Retinal fundus photograph
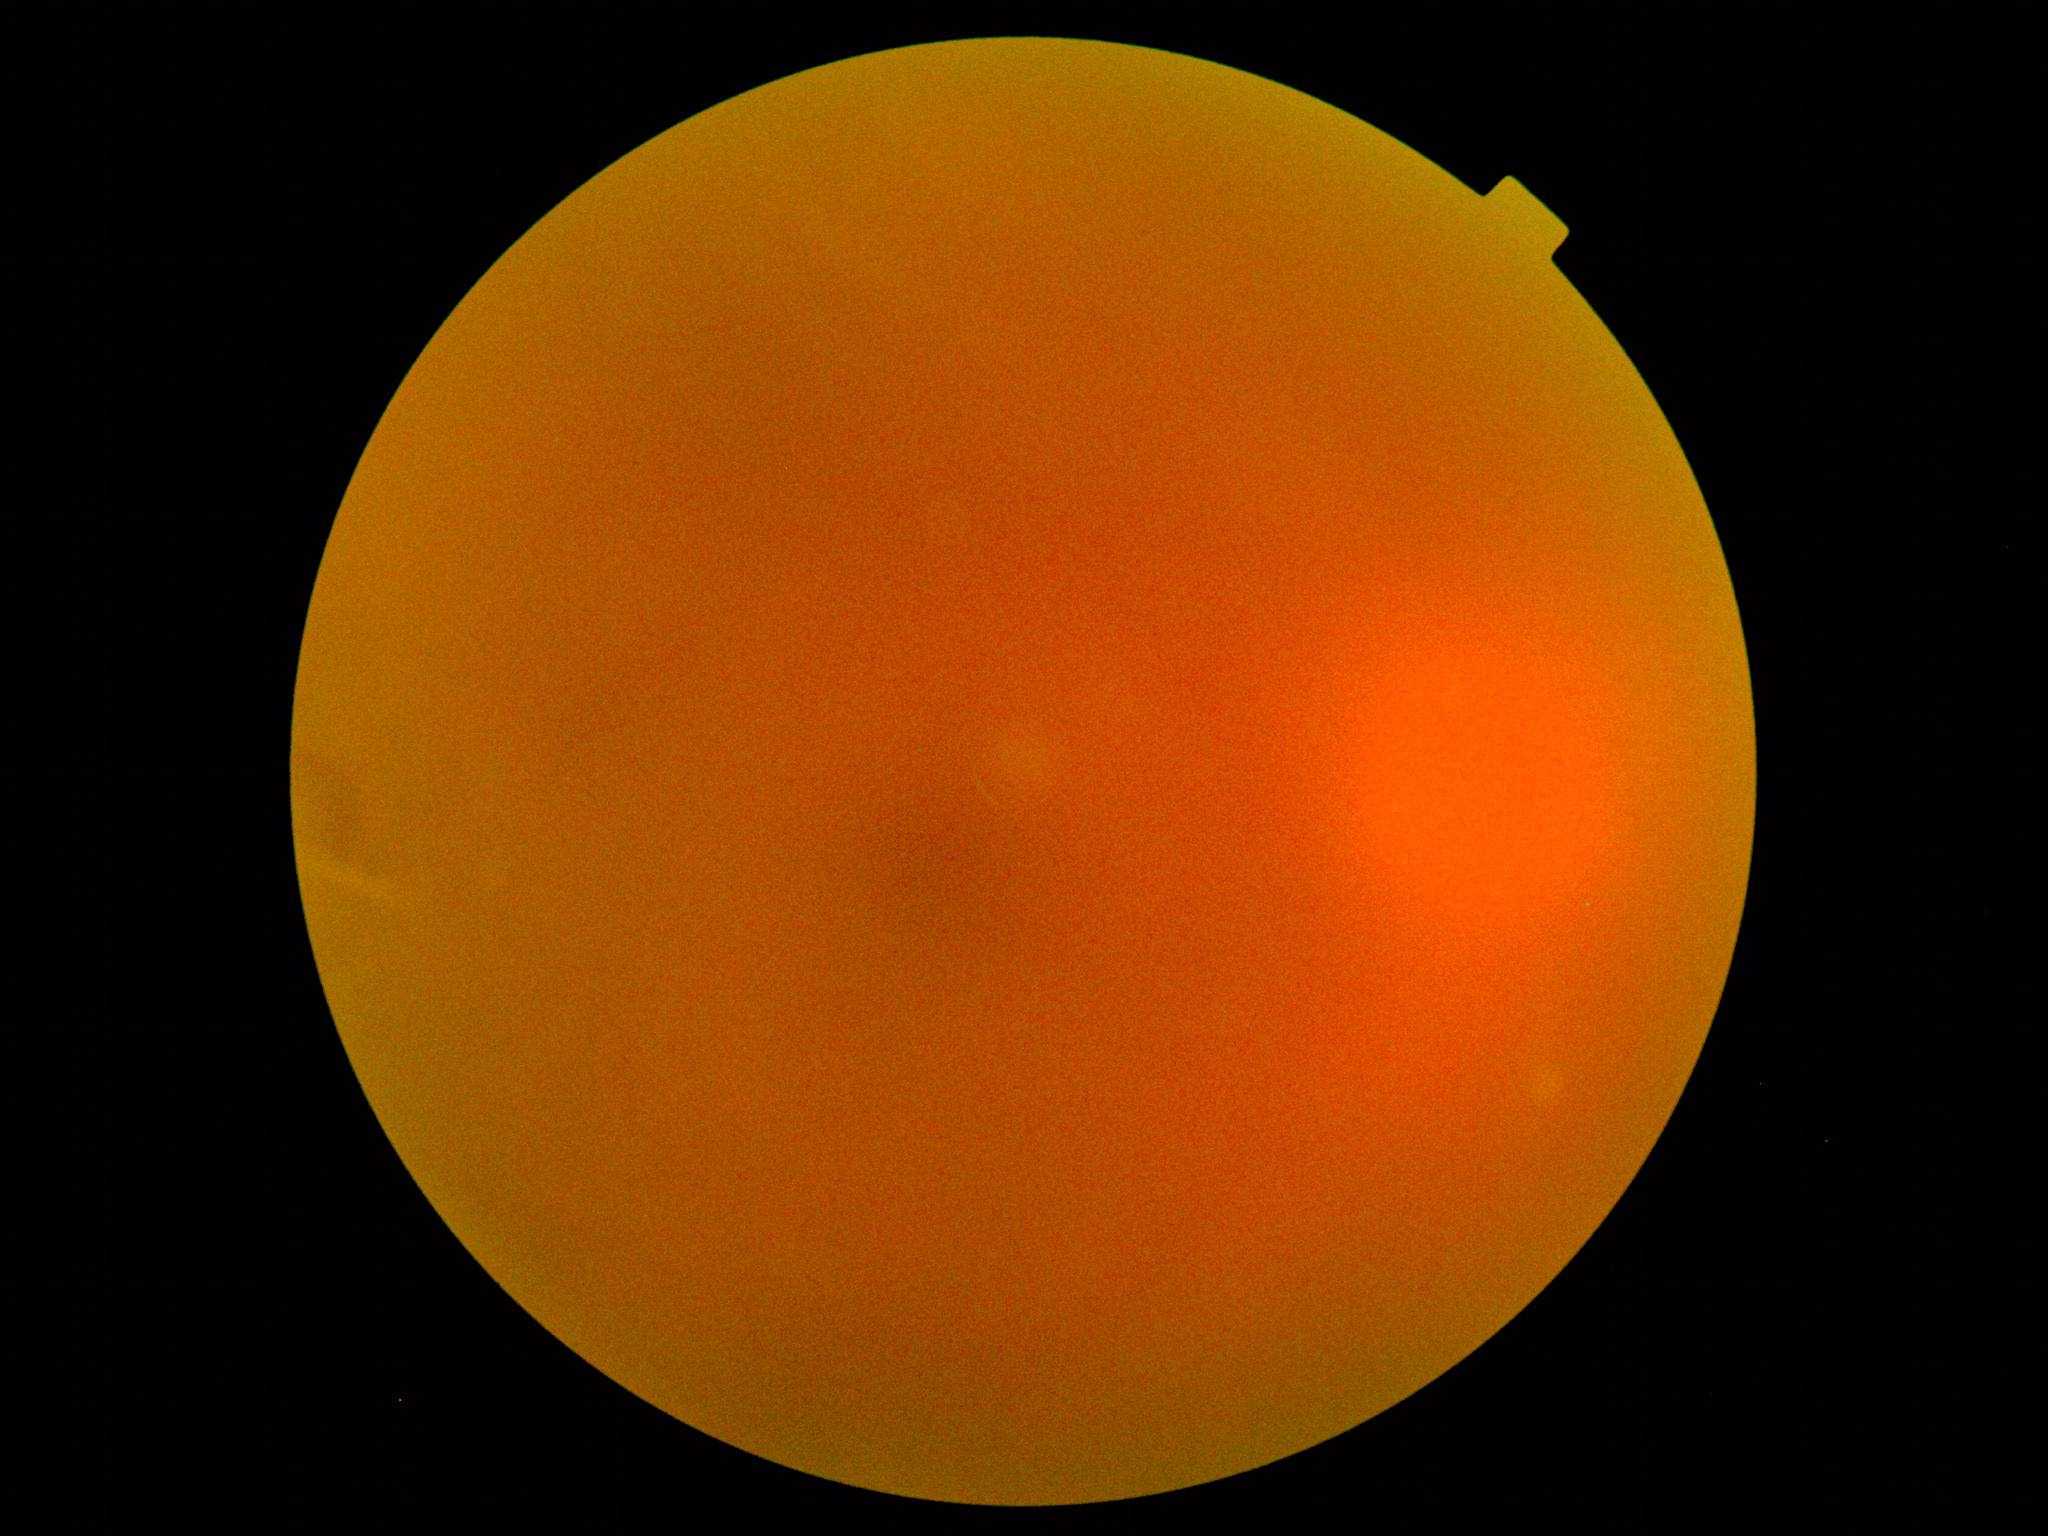

  dr_grade: ungradable due to poor image quality